Acquired with a NIDEK AFC-230, color fundus photograph: 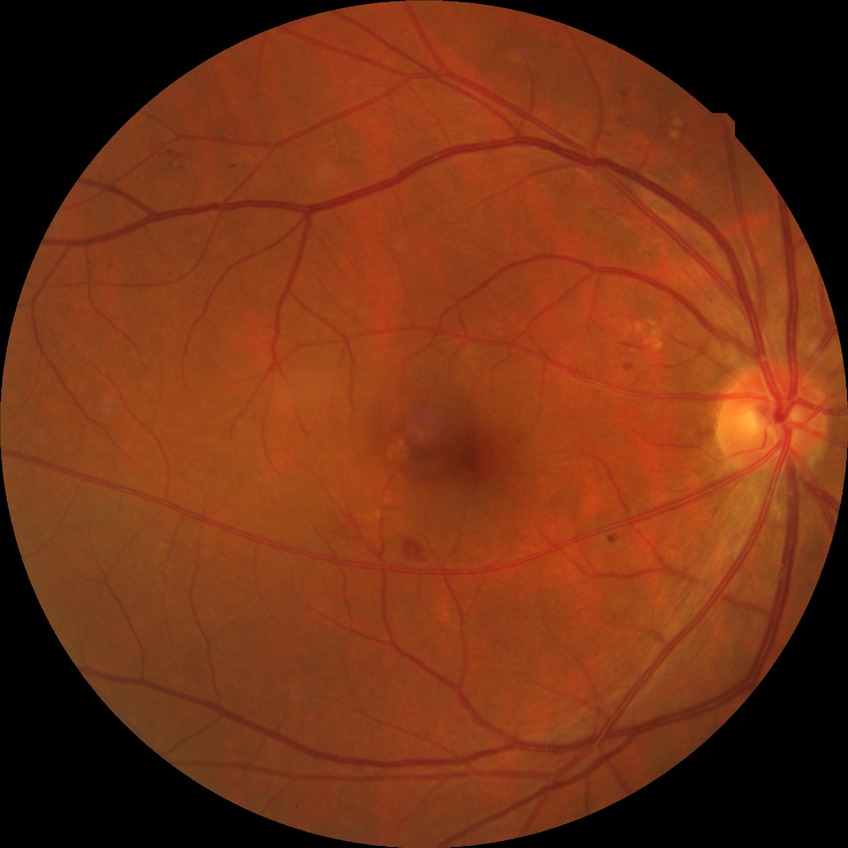
DR severity is SDR.